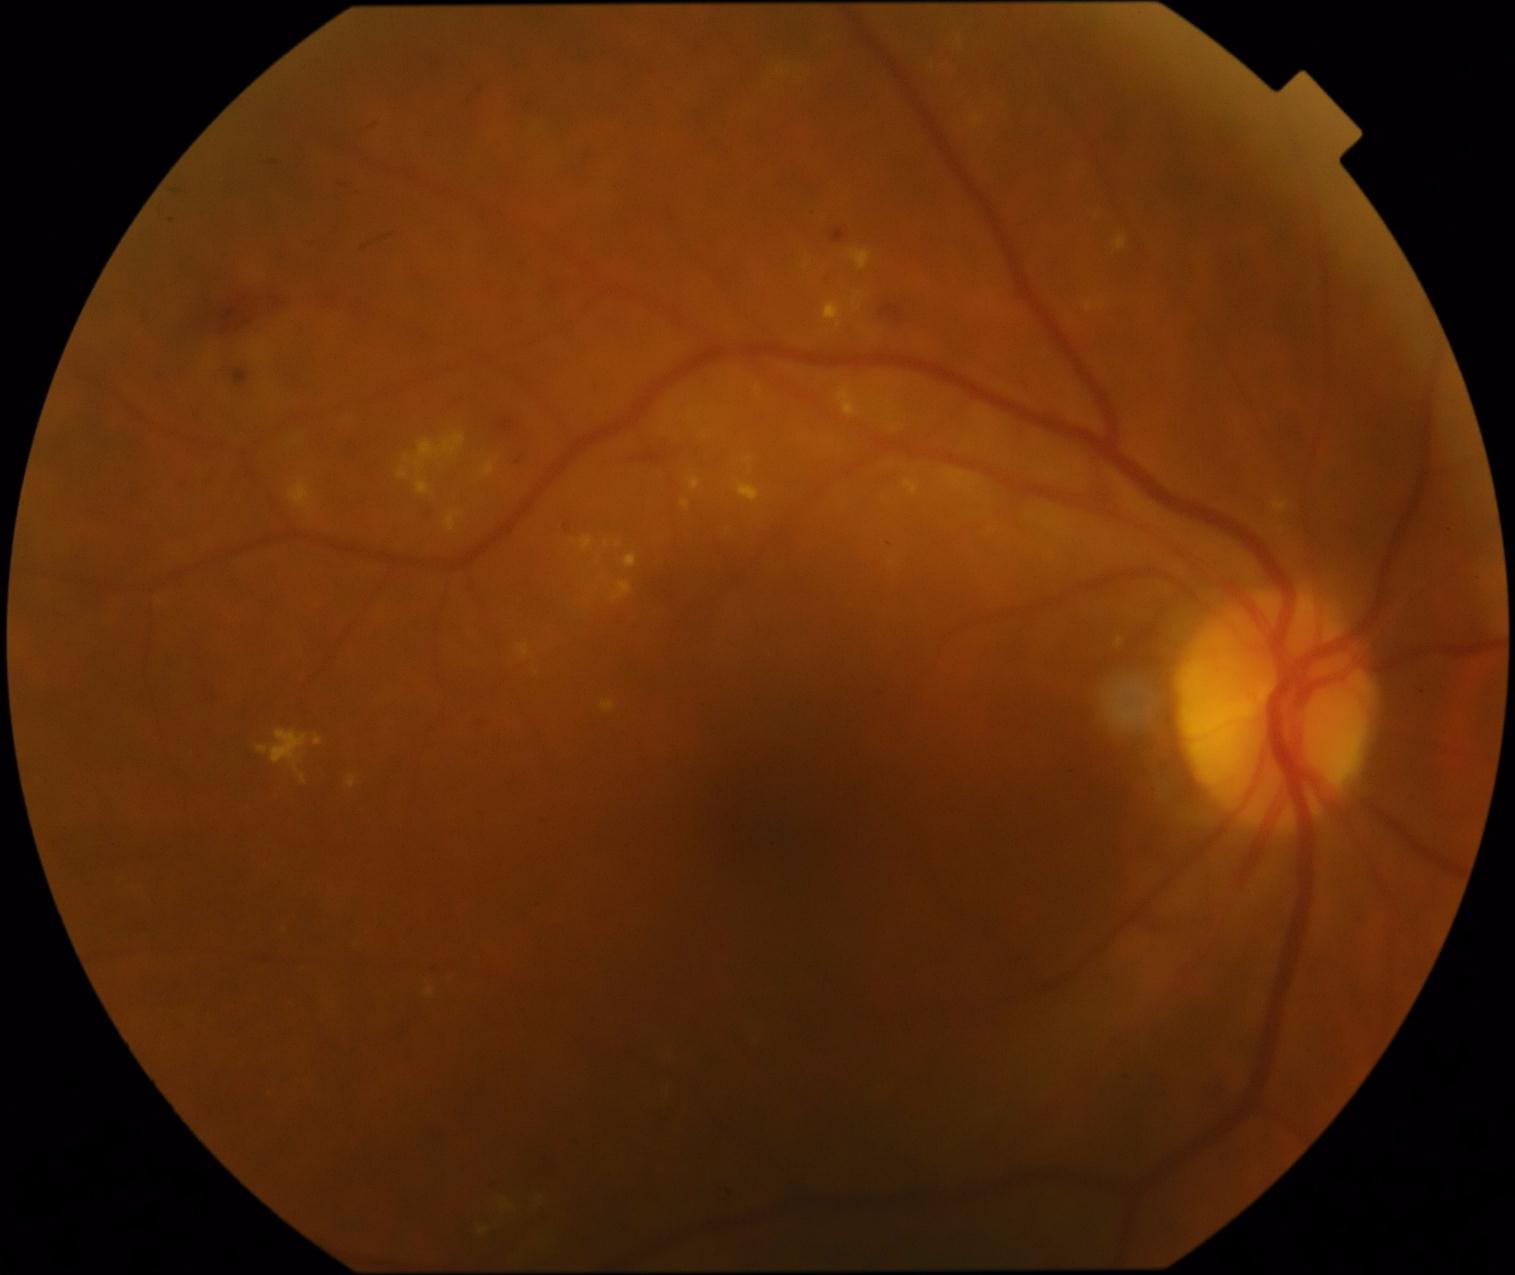 Diabetic retinopathy (DR) is 2
Representative lesions:
hard exudates (EXs) (continued): box(424, 989, 434, 997), box(972, 118, 984, 126), box(624, 554, 637, 569), box(744, 458, 752, 464), box(602, 701, 615, 712), box(404, 433, 465, 475), box(852, 292, 866, 311), box(689, 477, 702, 491), box(736, 482, 760, 502), box(1085, 301, 1106, 311), box(614, 583, 633, 601), box(824, 301, 844, 329), box(518, 645, 530, 658), box(837, 386, 860, 419), box(481, 461, 495, 477)
Additional small EXs near x=758 y=389, x=507 y=1206, x=705 y=438, x=895 y=430, x=607 y=545